379 x 379 pixels · mydriatic · disc-centered fundus crop:
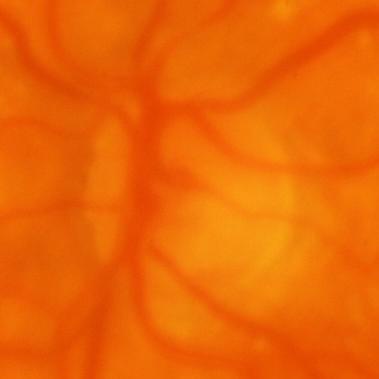

Finding = glaucomatous optic neuropathy.